45° FOV. CFP:
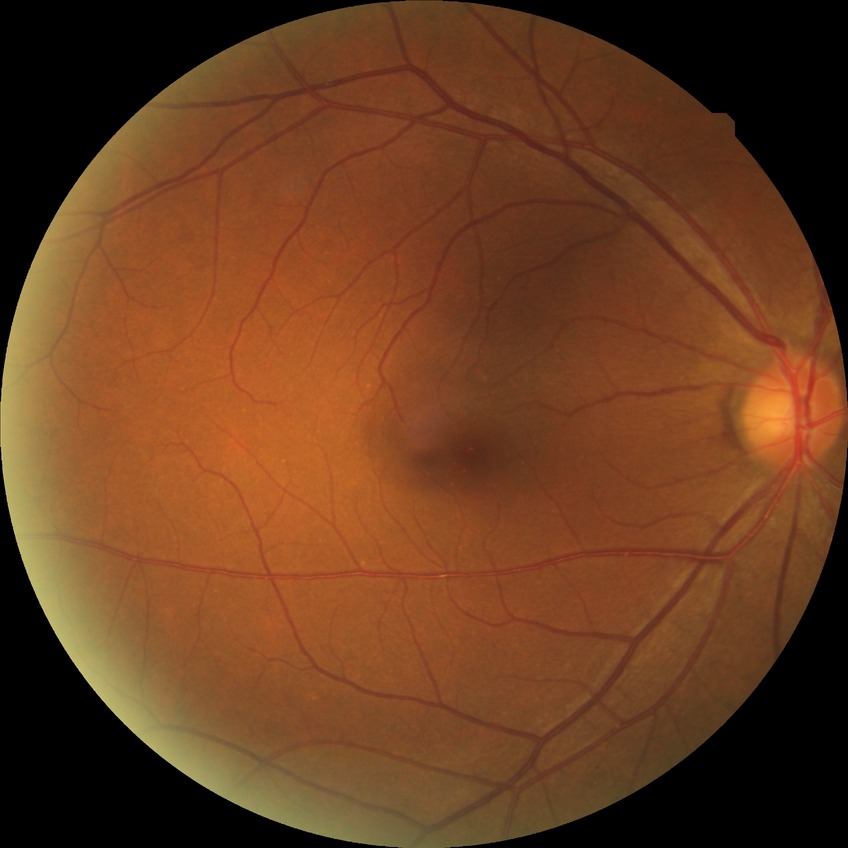
Diabetic retinopathy (DR): NDR (no diabetic retinopathy).